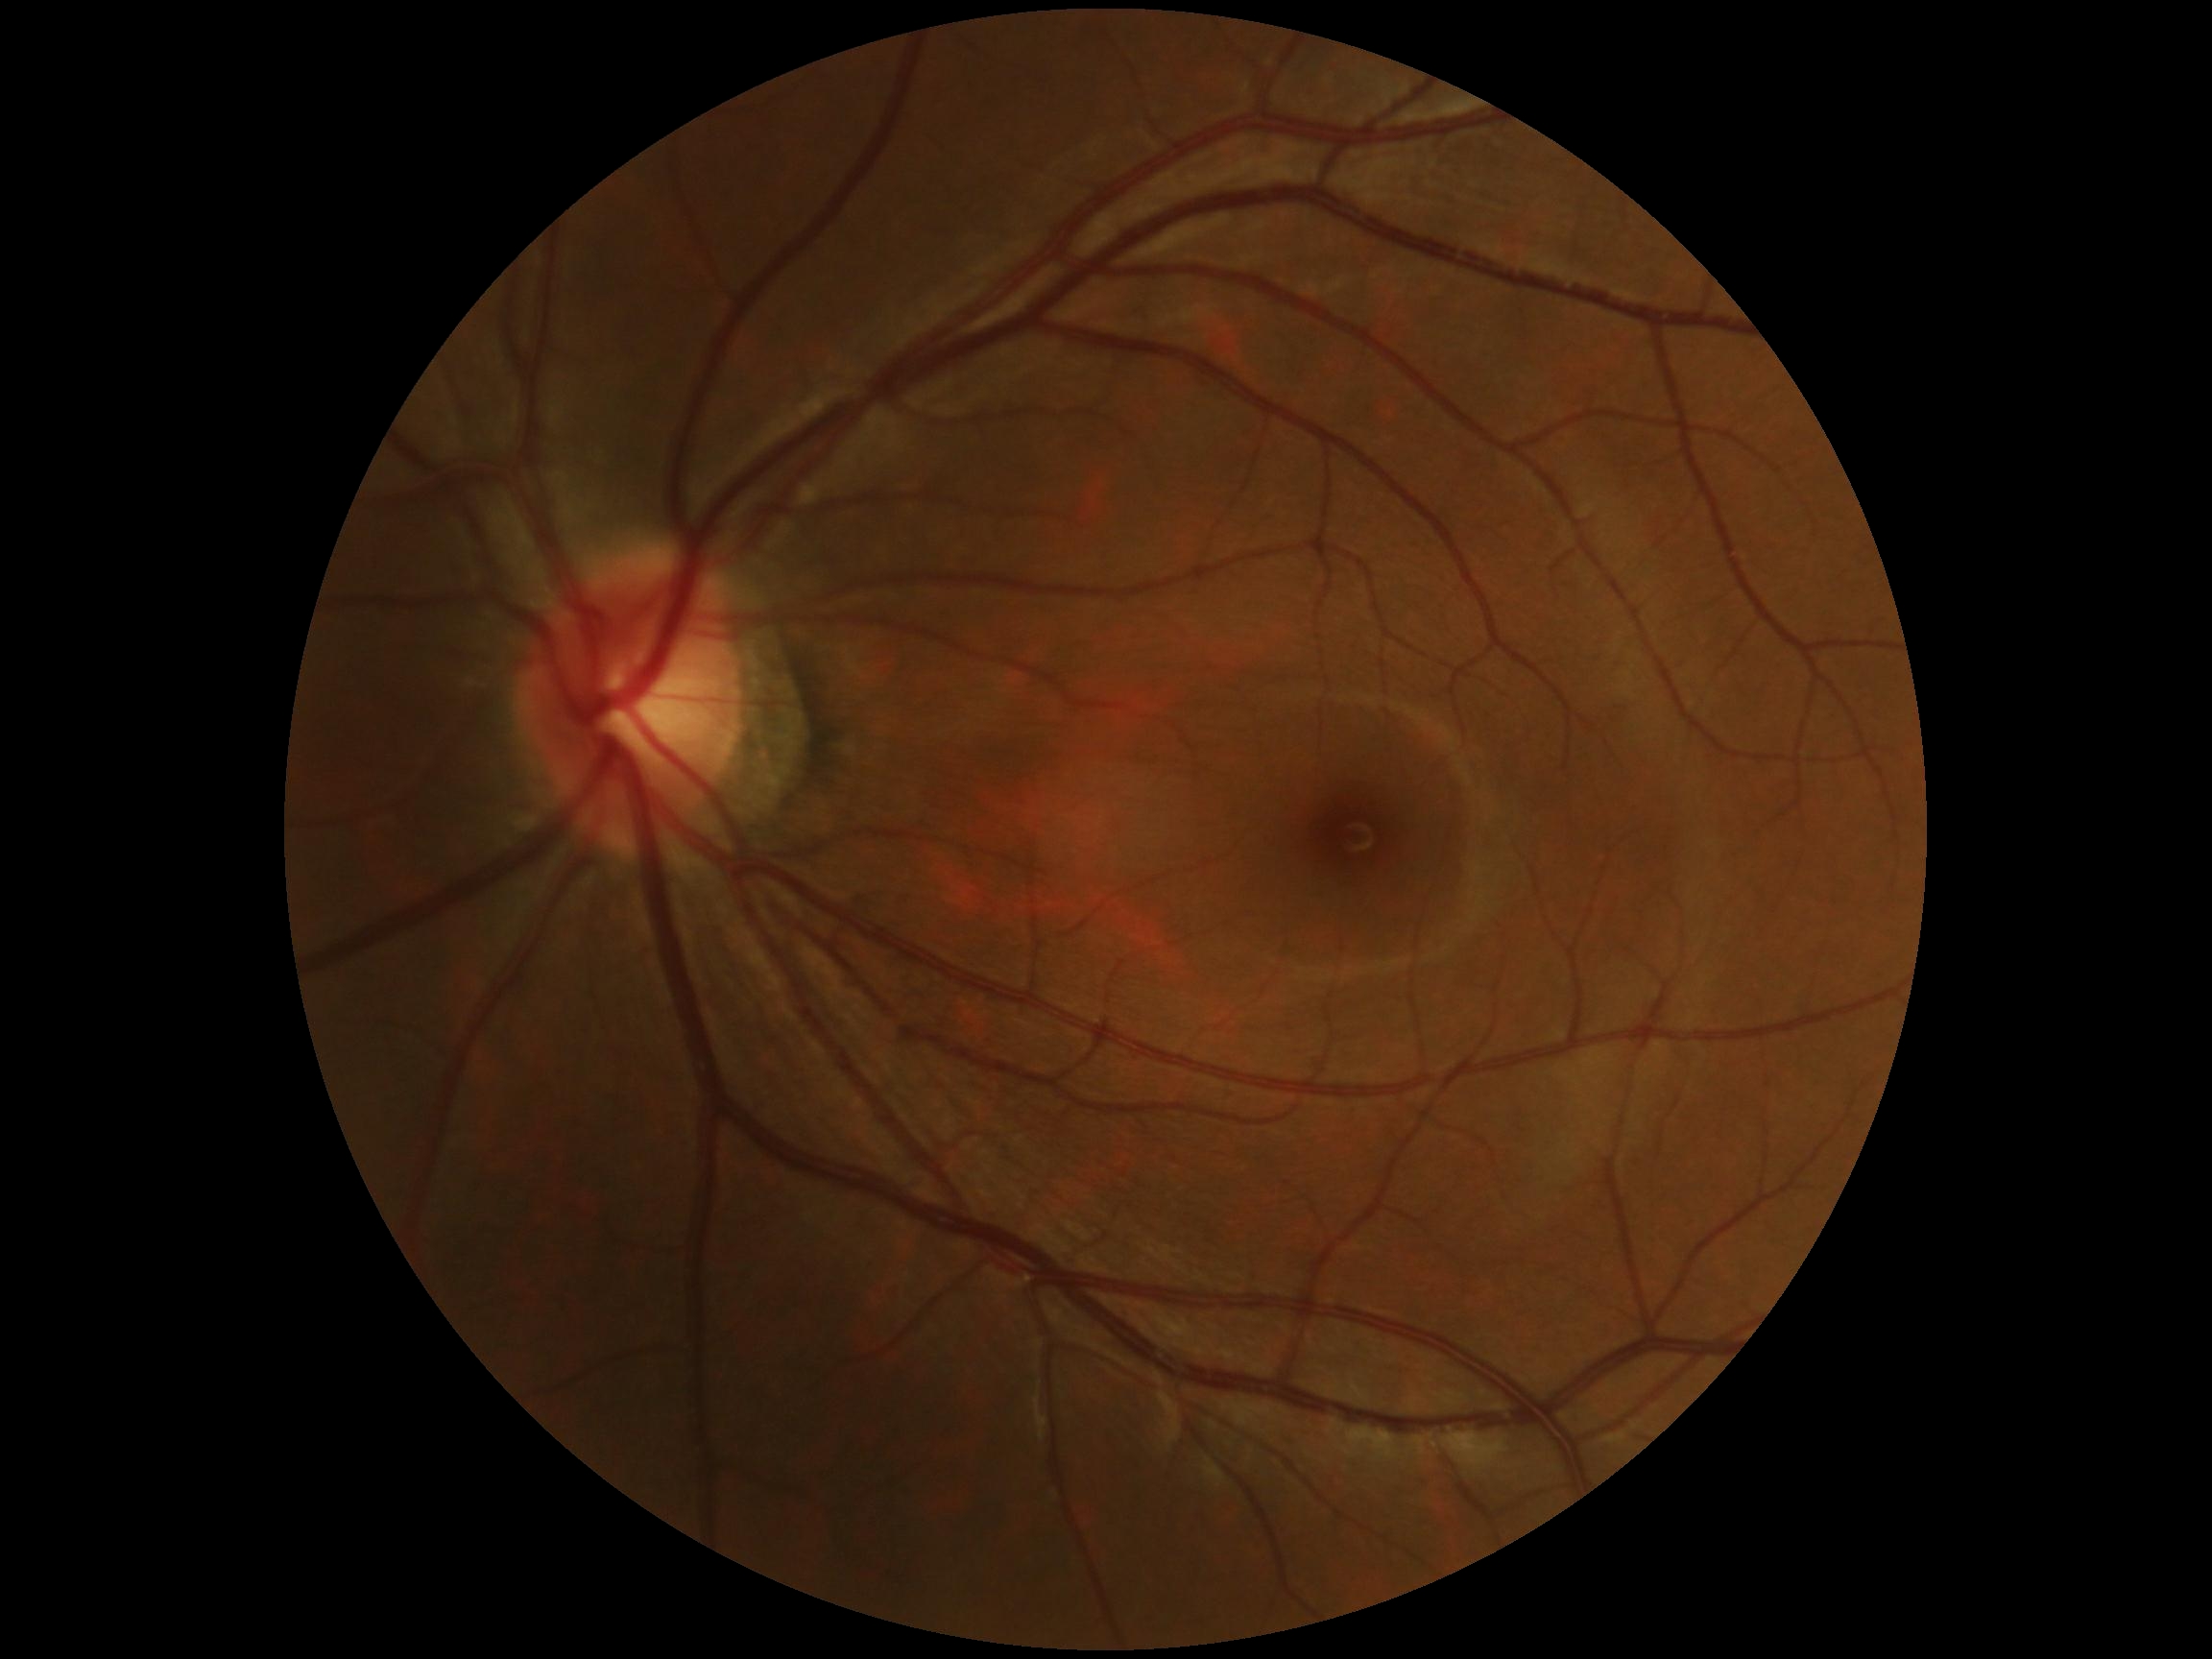
Retinopathy grade: no apparent diabetic retinopathy (0). No DR findings.